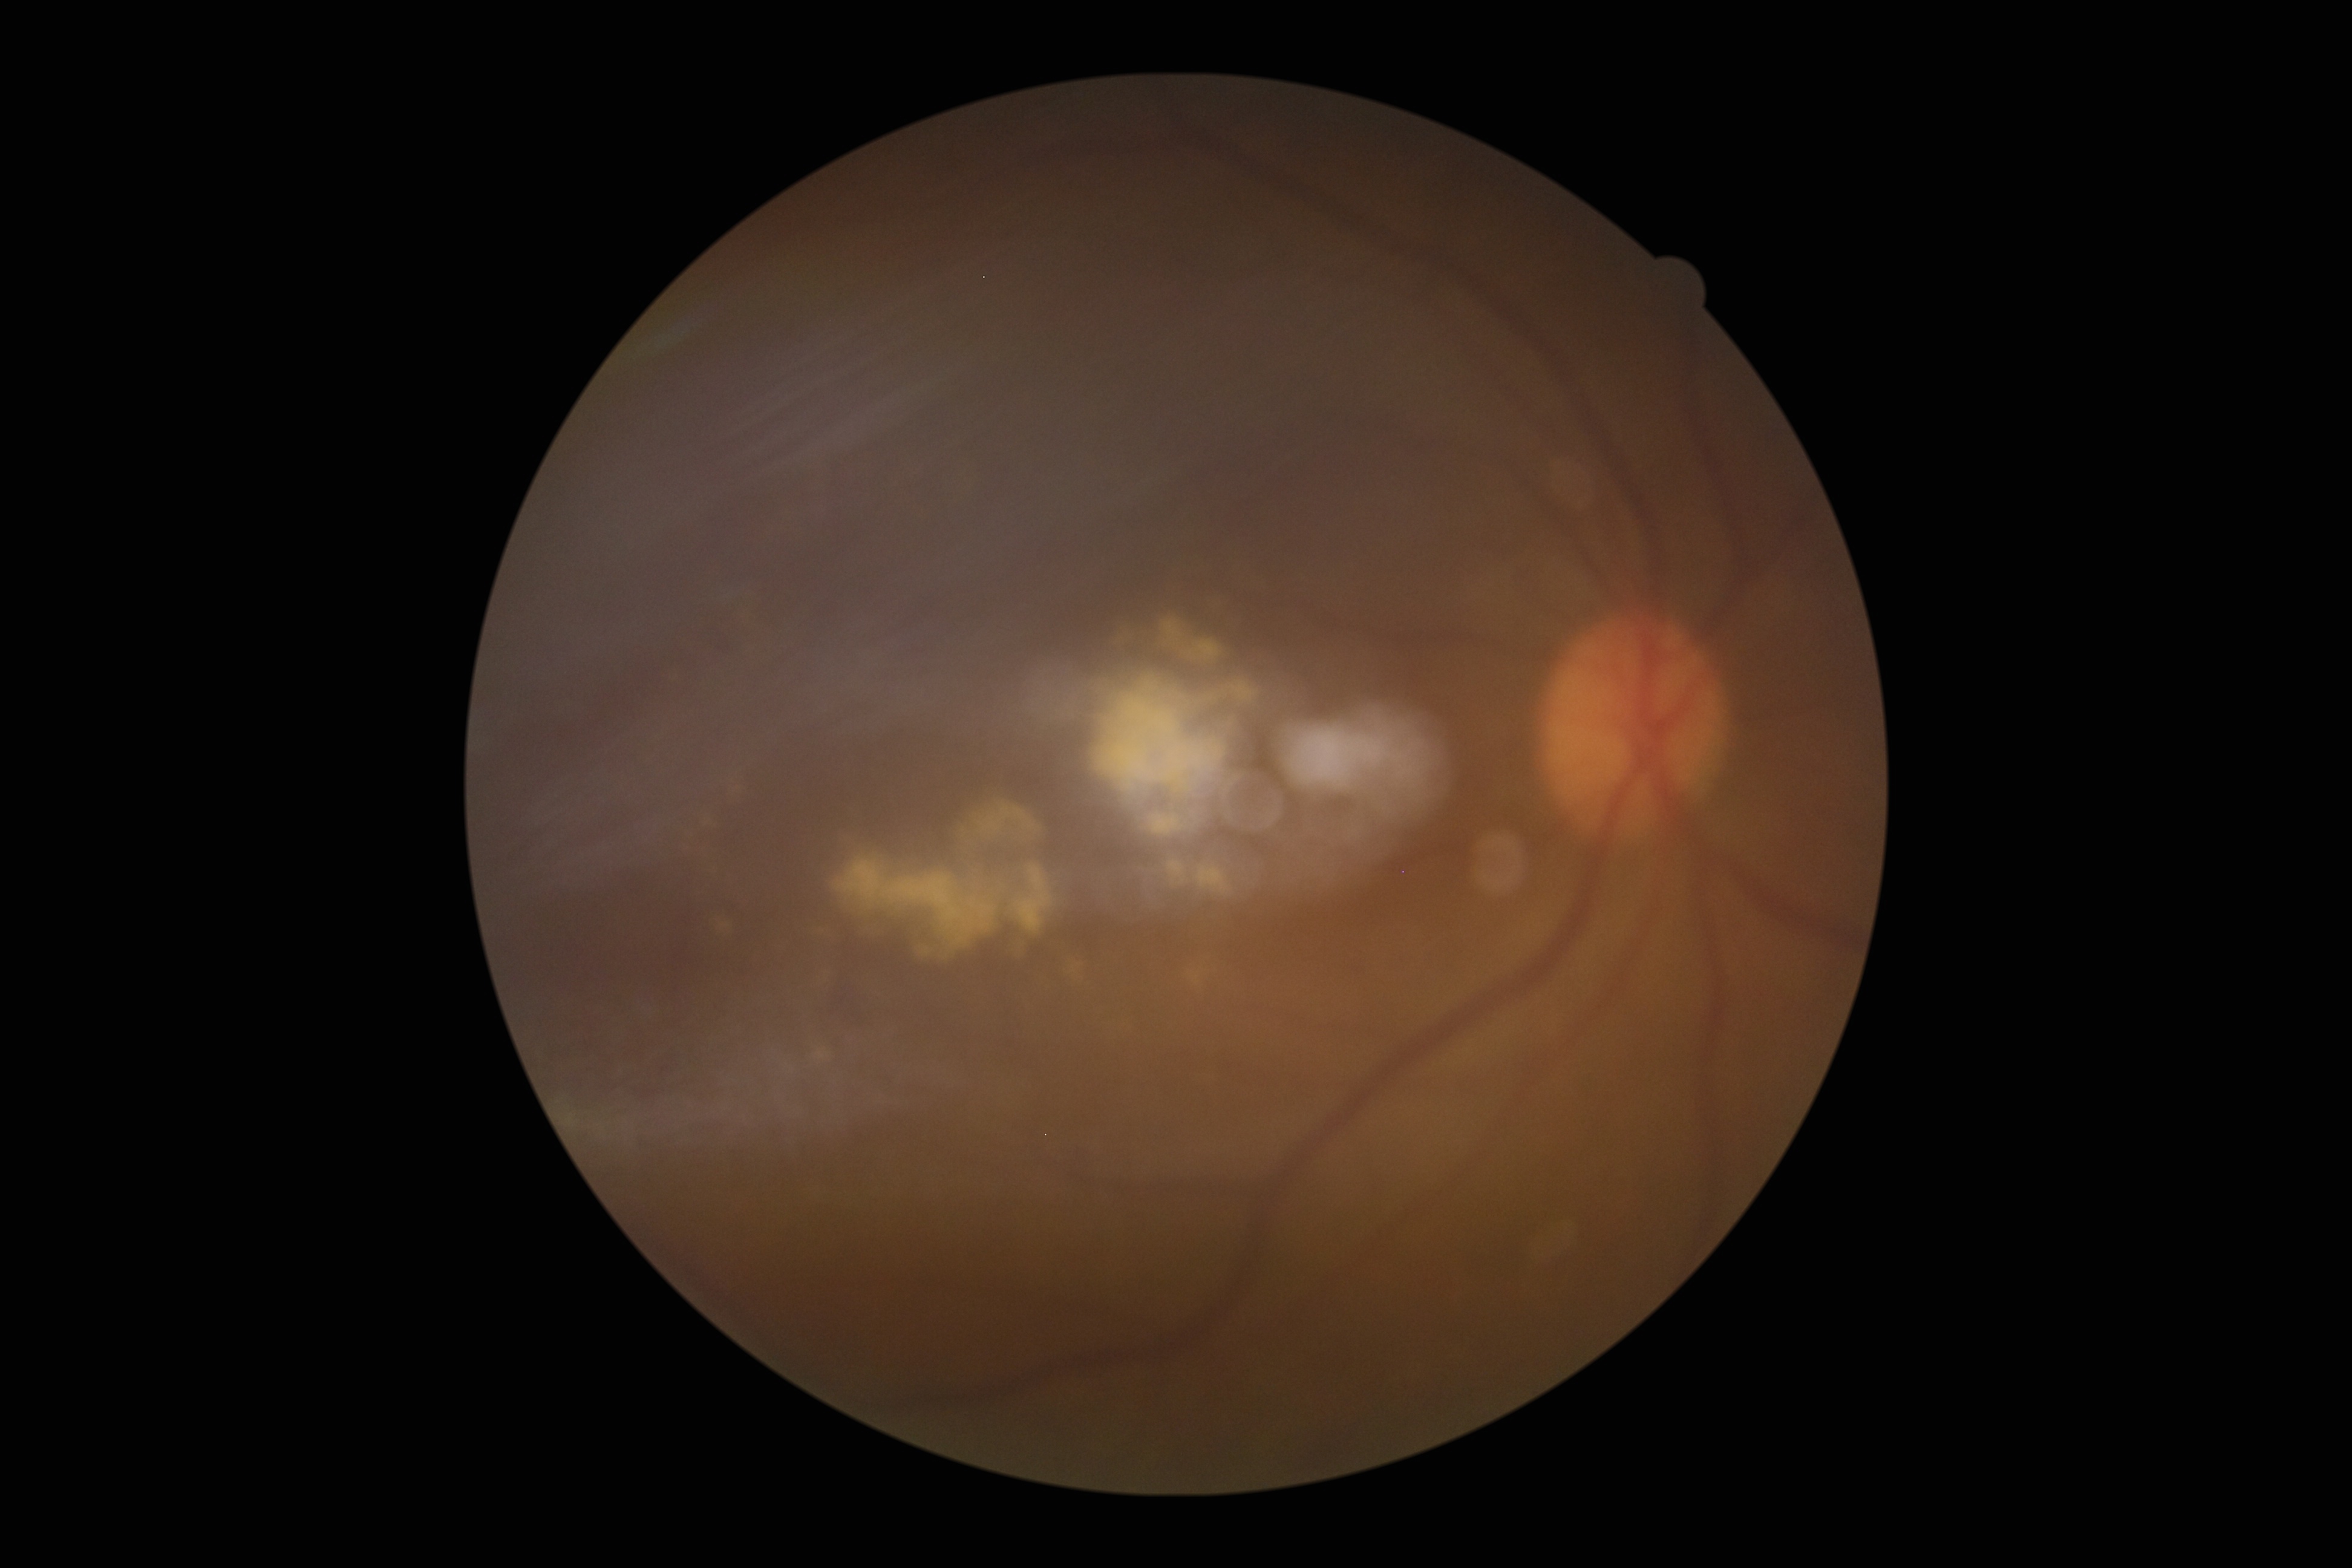 DR severity: 2/4.